Acquired with a Remidio FOP fundus camera: 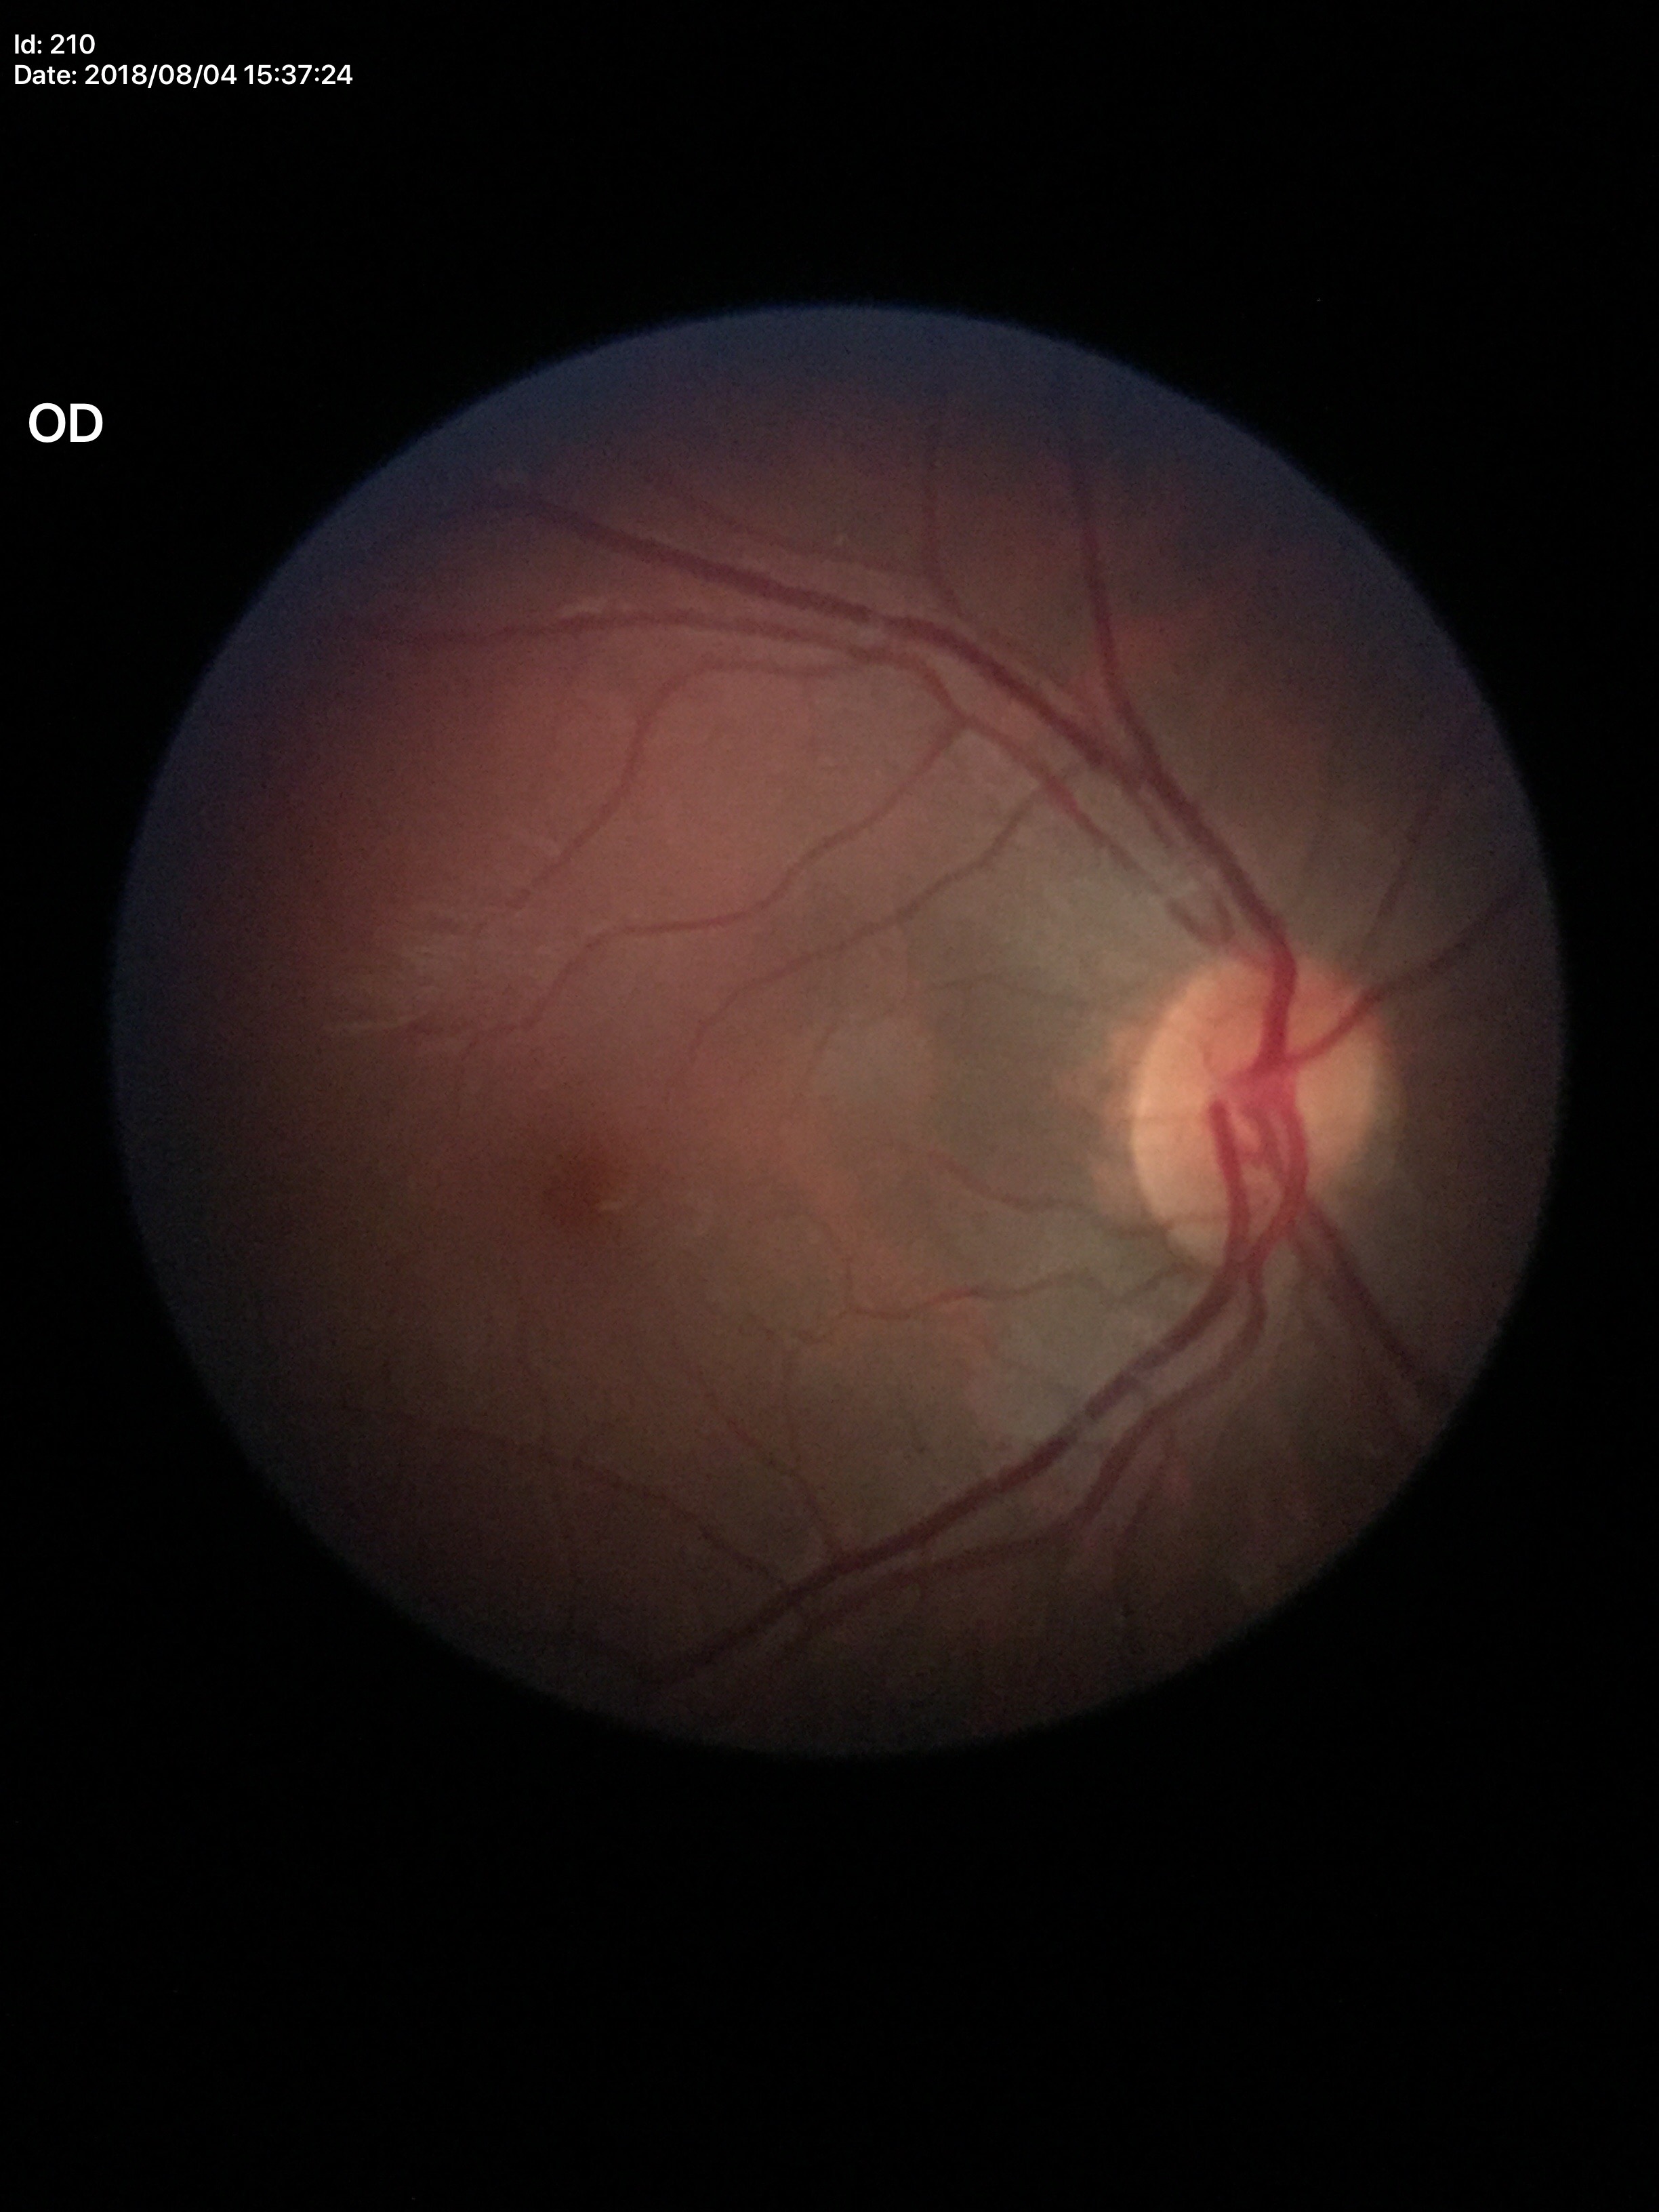 No glaucomatous findings.
Vertical CDR is 0.42.
Horizontal cup-disc ratio of 0.49.
Area C/D ratio of 0.22.